Wide-field contact fundus photograph of an infant · 100° field of view (Phoenix ICON):
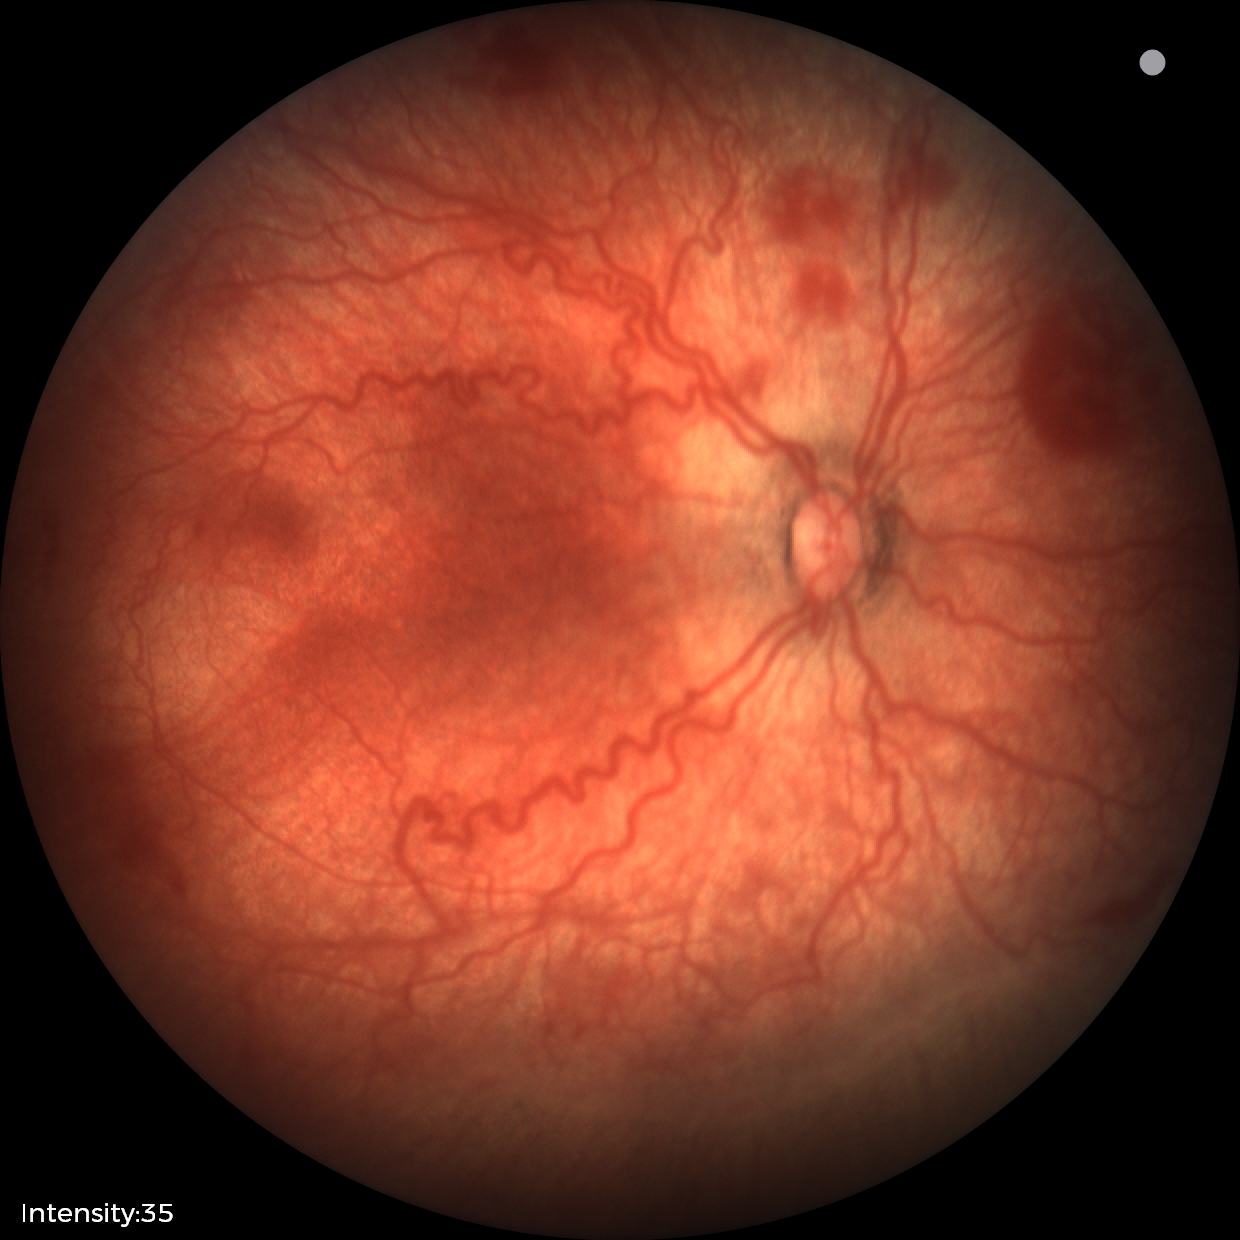

Examination diagnosed as retinopathy of prematurity stage 2.
With plus disease.